1932x1932px.
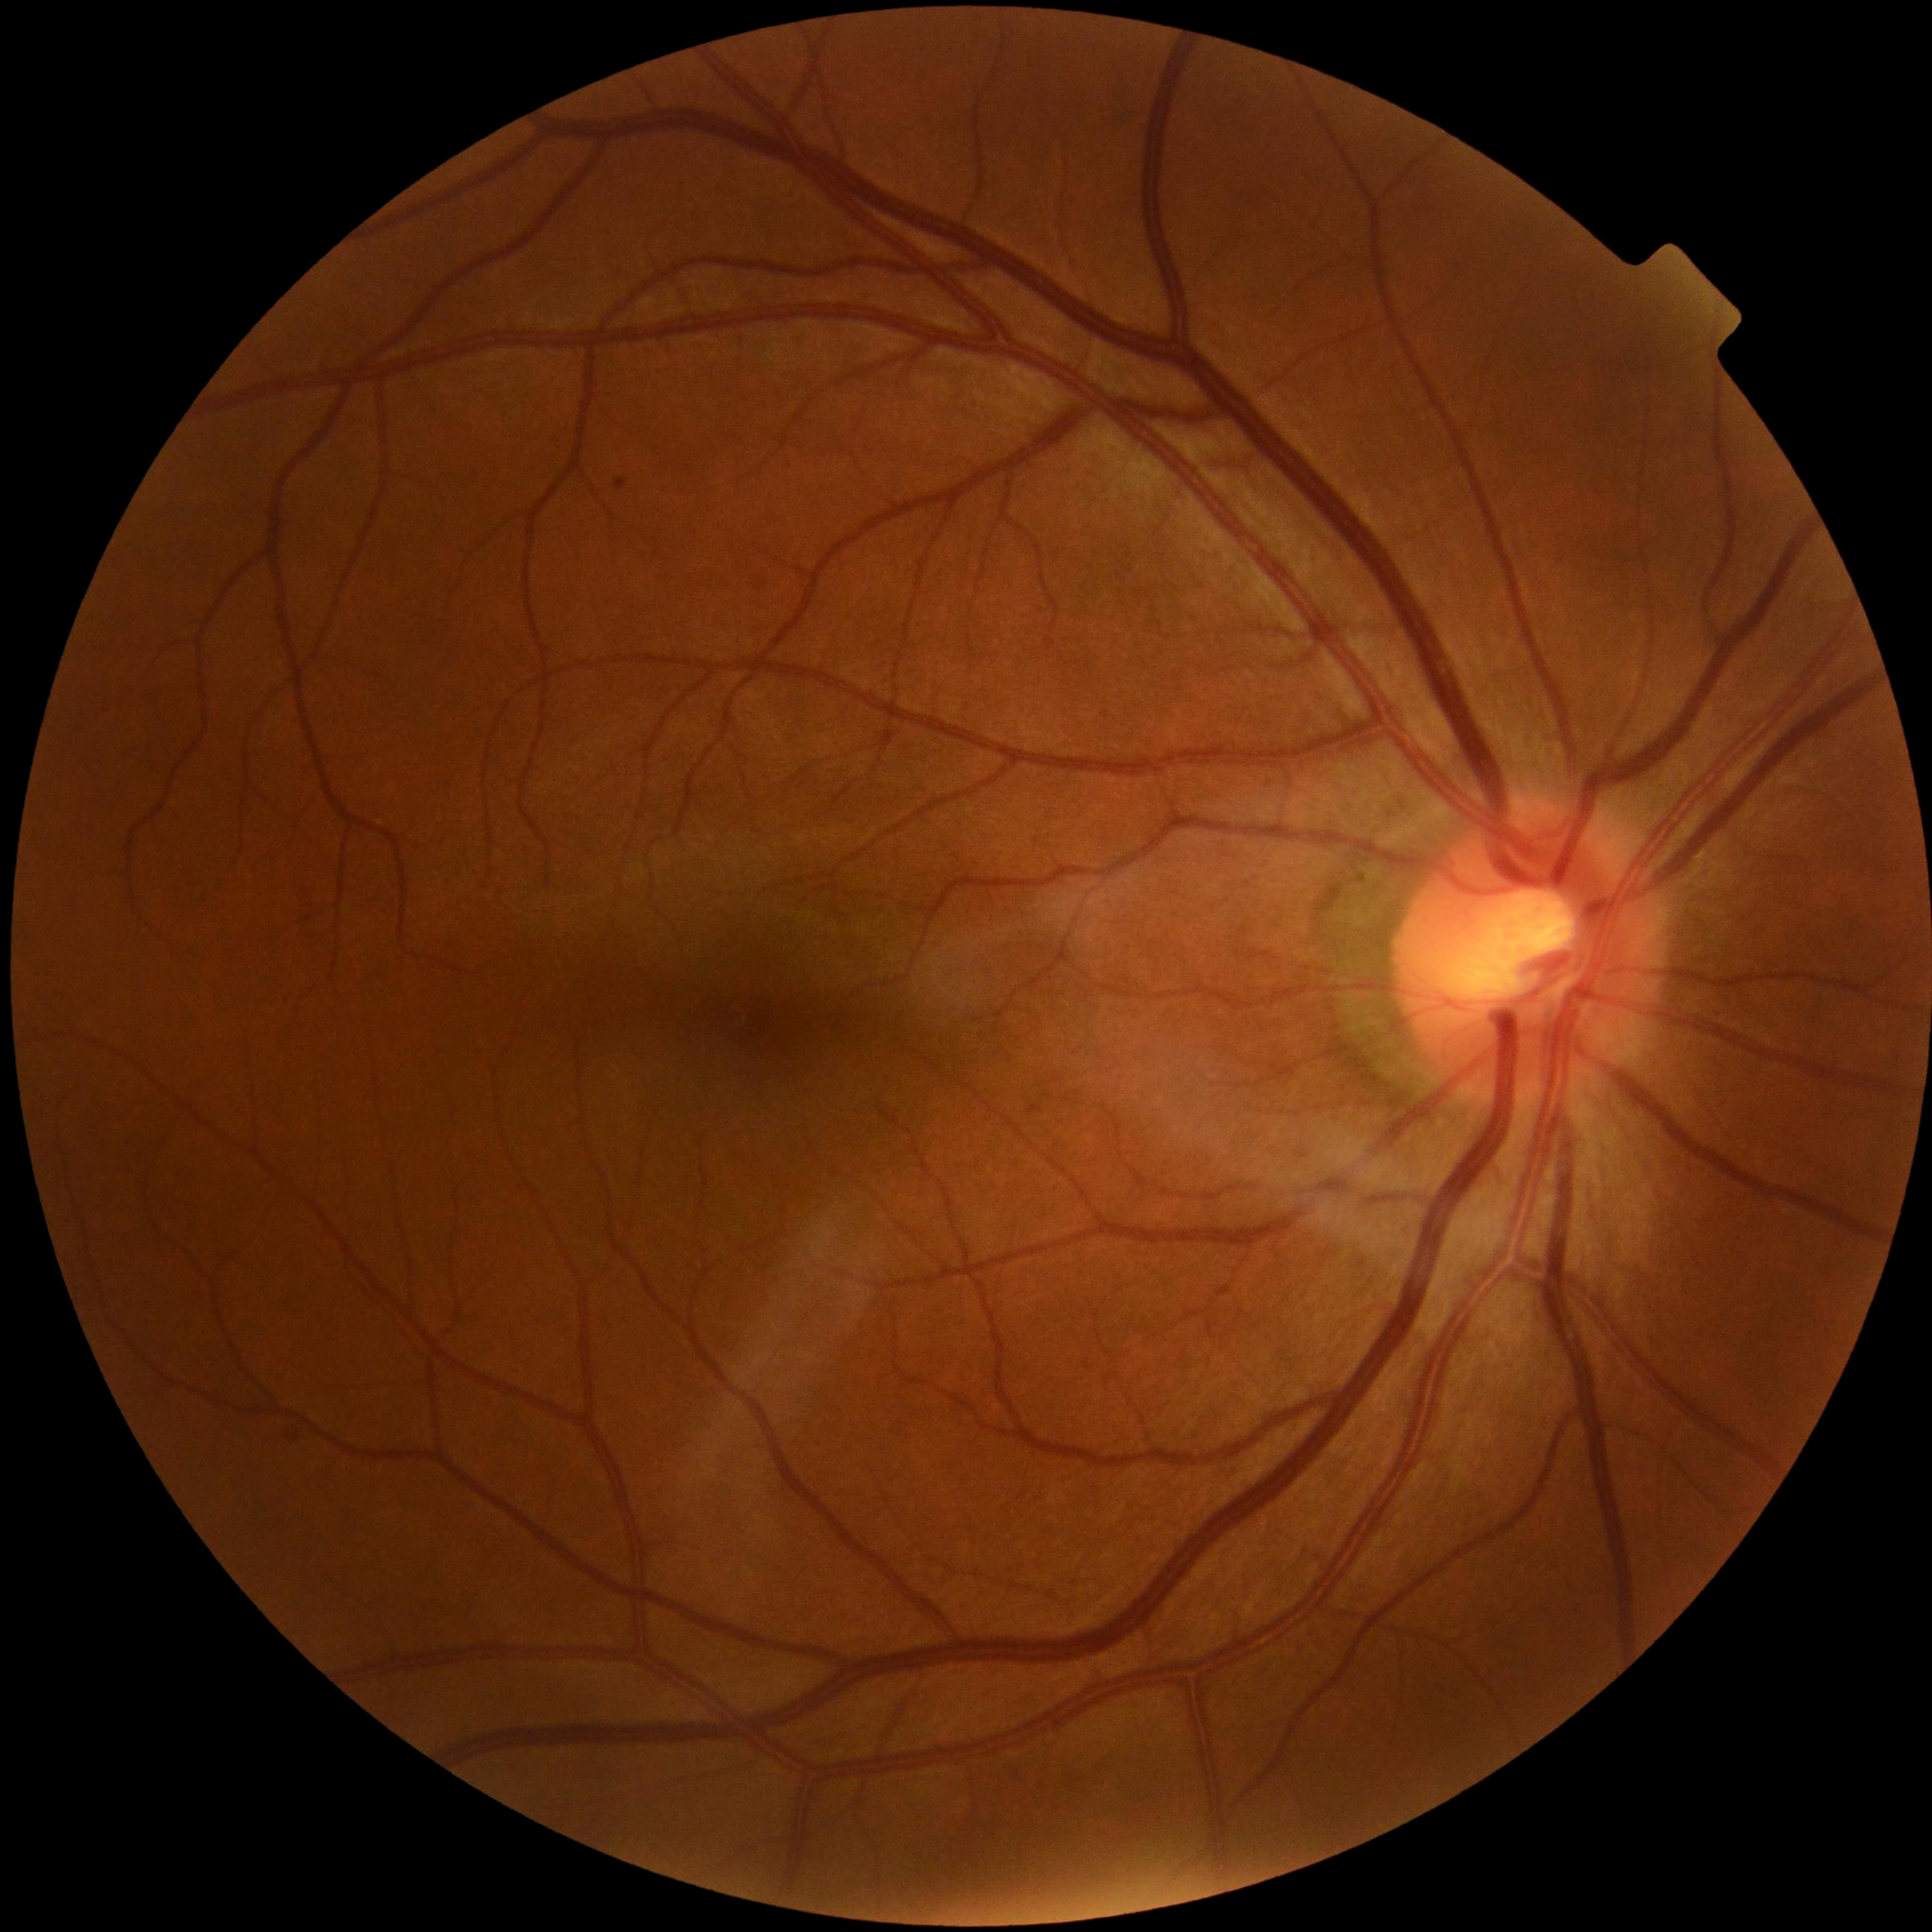 Diabetic retinopathy (DR): grade 0 (no apparent retinopathy). No diabetic retinal disease findings.